No pharmacologic dilation
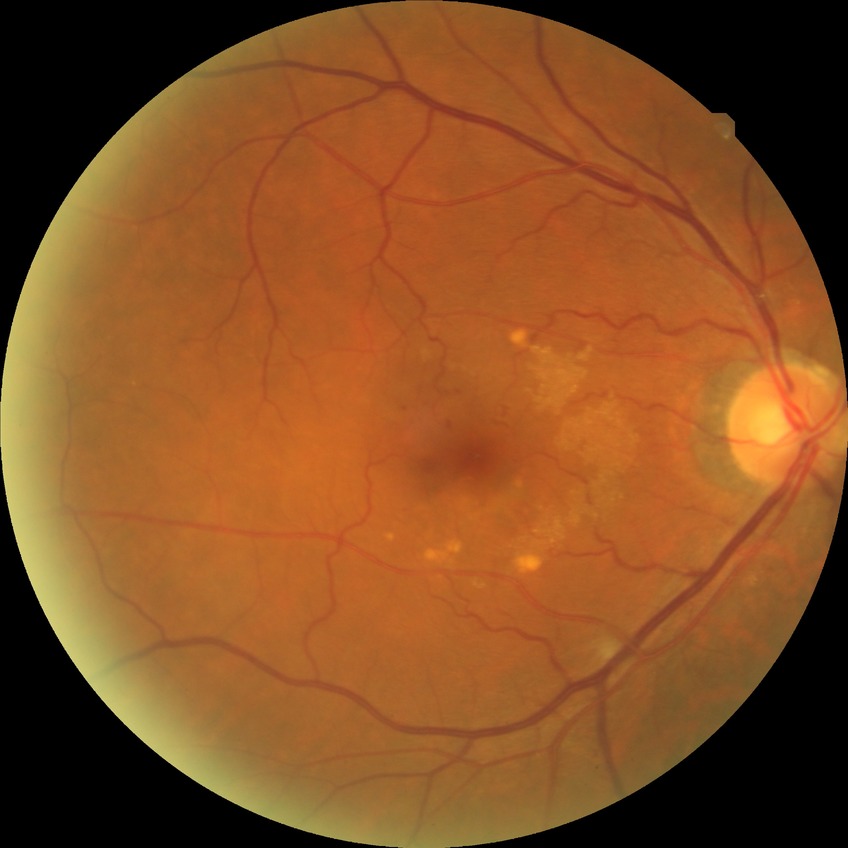
Assessment:
- diabetic retinopathy grade — simple diabetic retinopathy